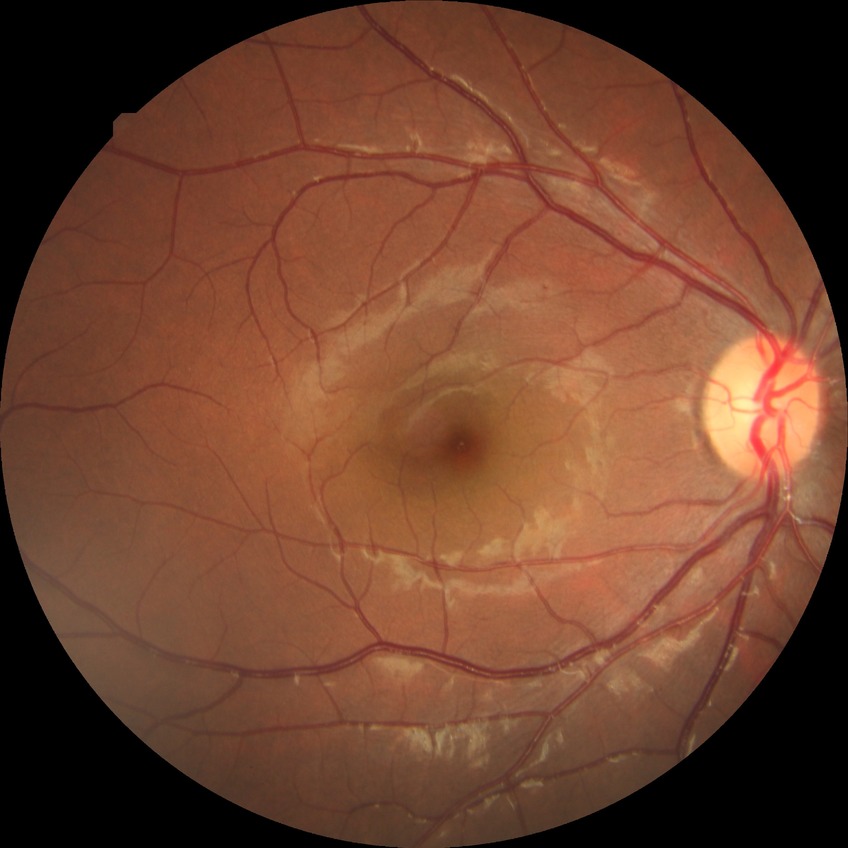 diabetic retinopathy (DR): simple diabetic retinopathy (SDR).